Phoenix ICON wide-field infant fundus image.
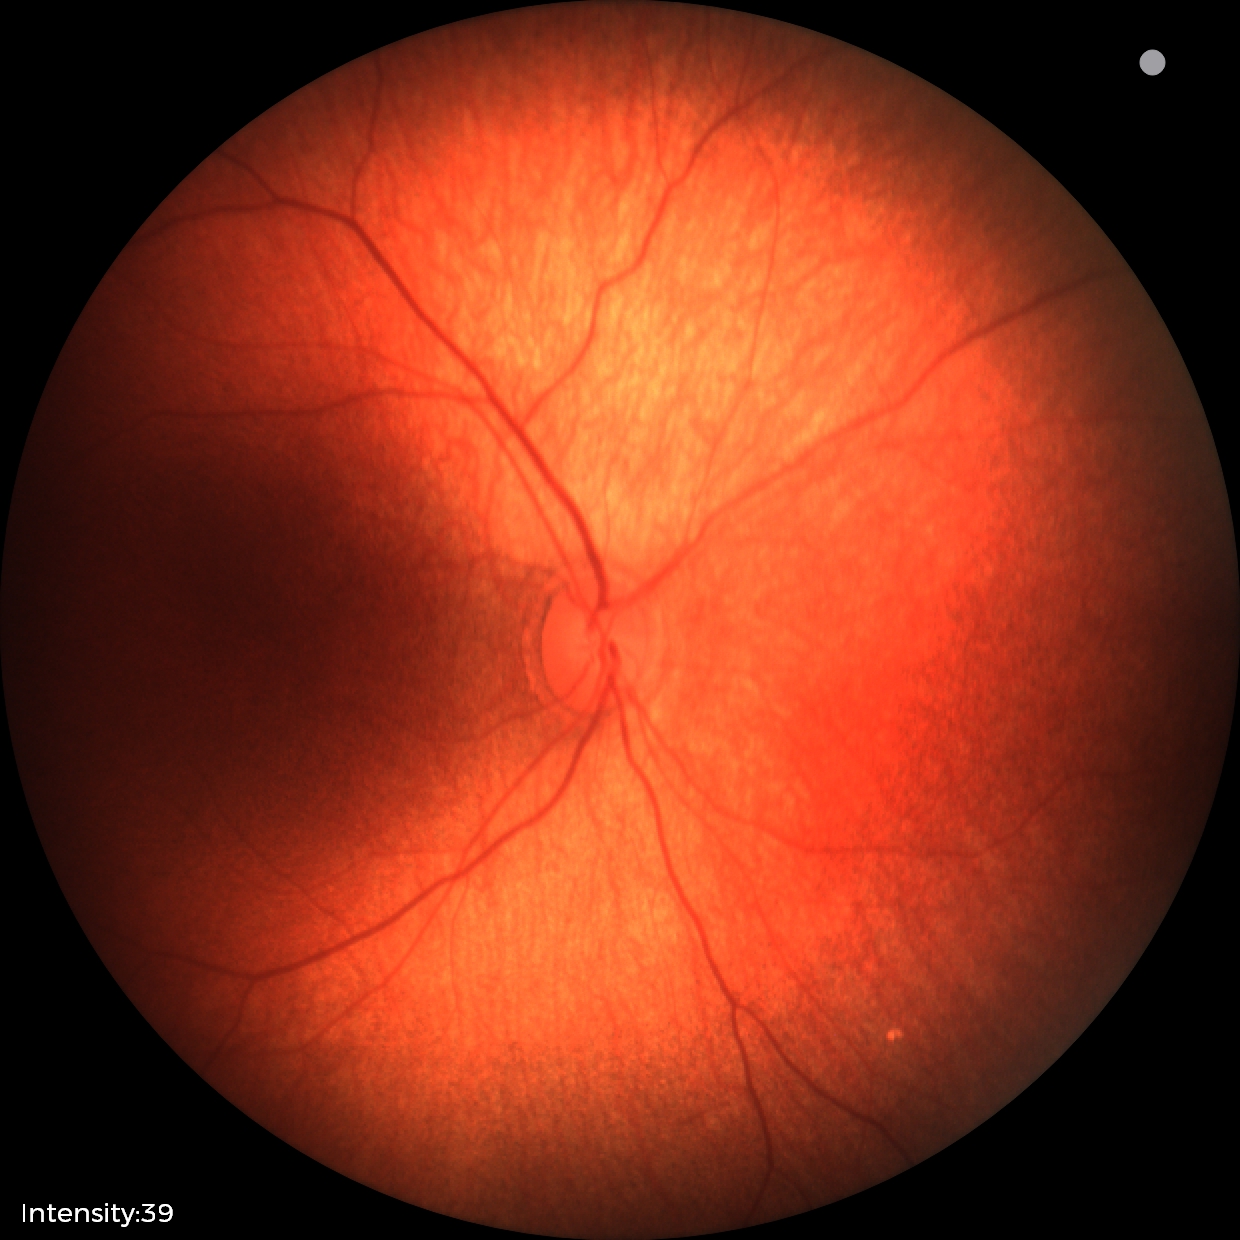

Impression = no pathology identified.